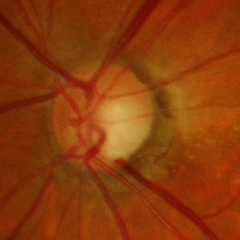 Q: What is the glaucoma diagnosis?
A: Advanced glaucoma.